1932x1910px.
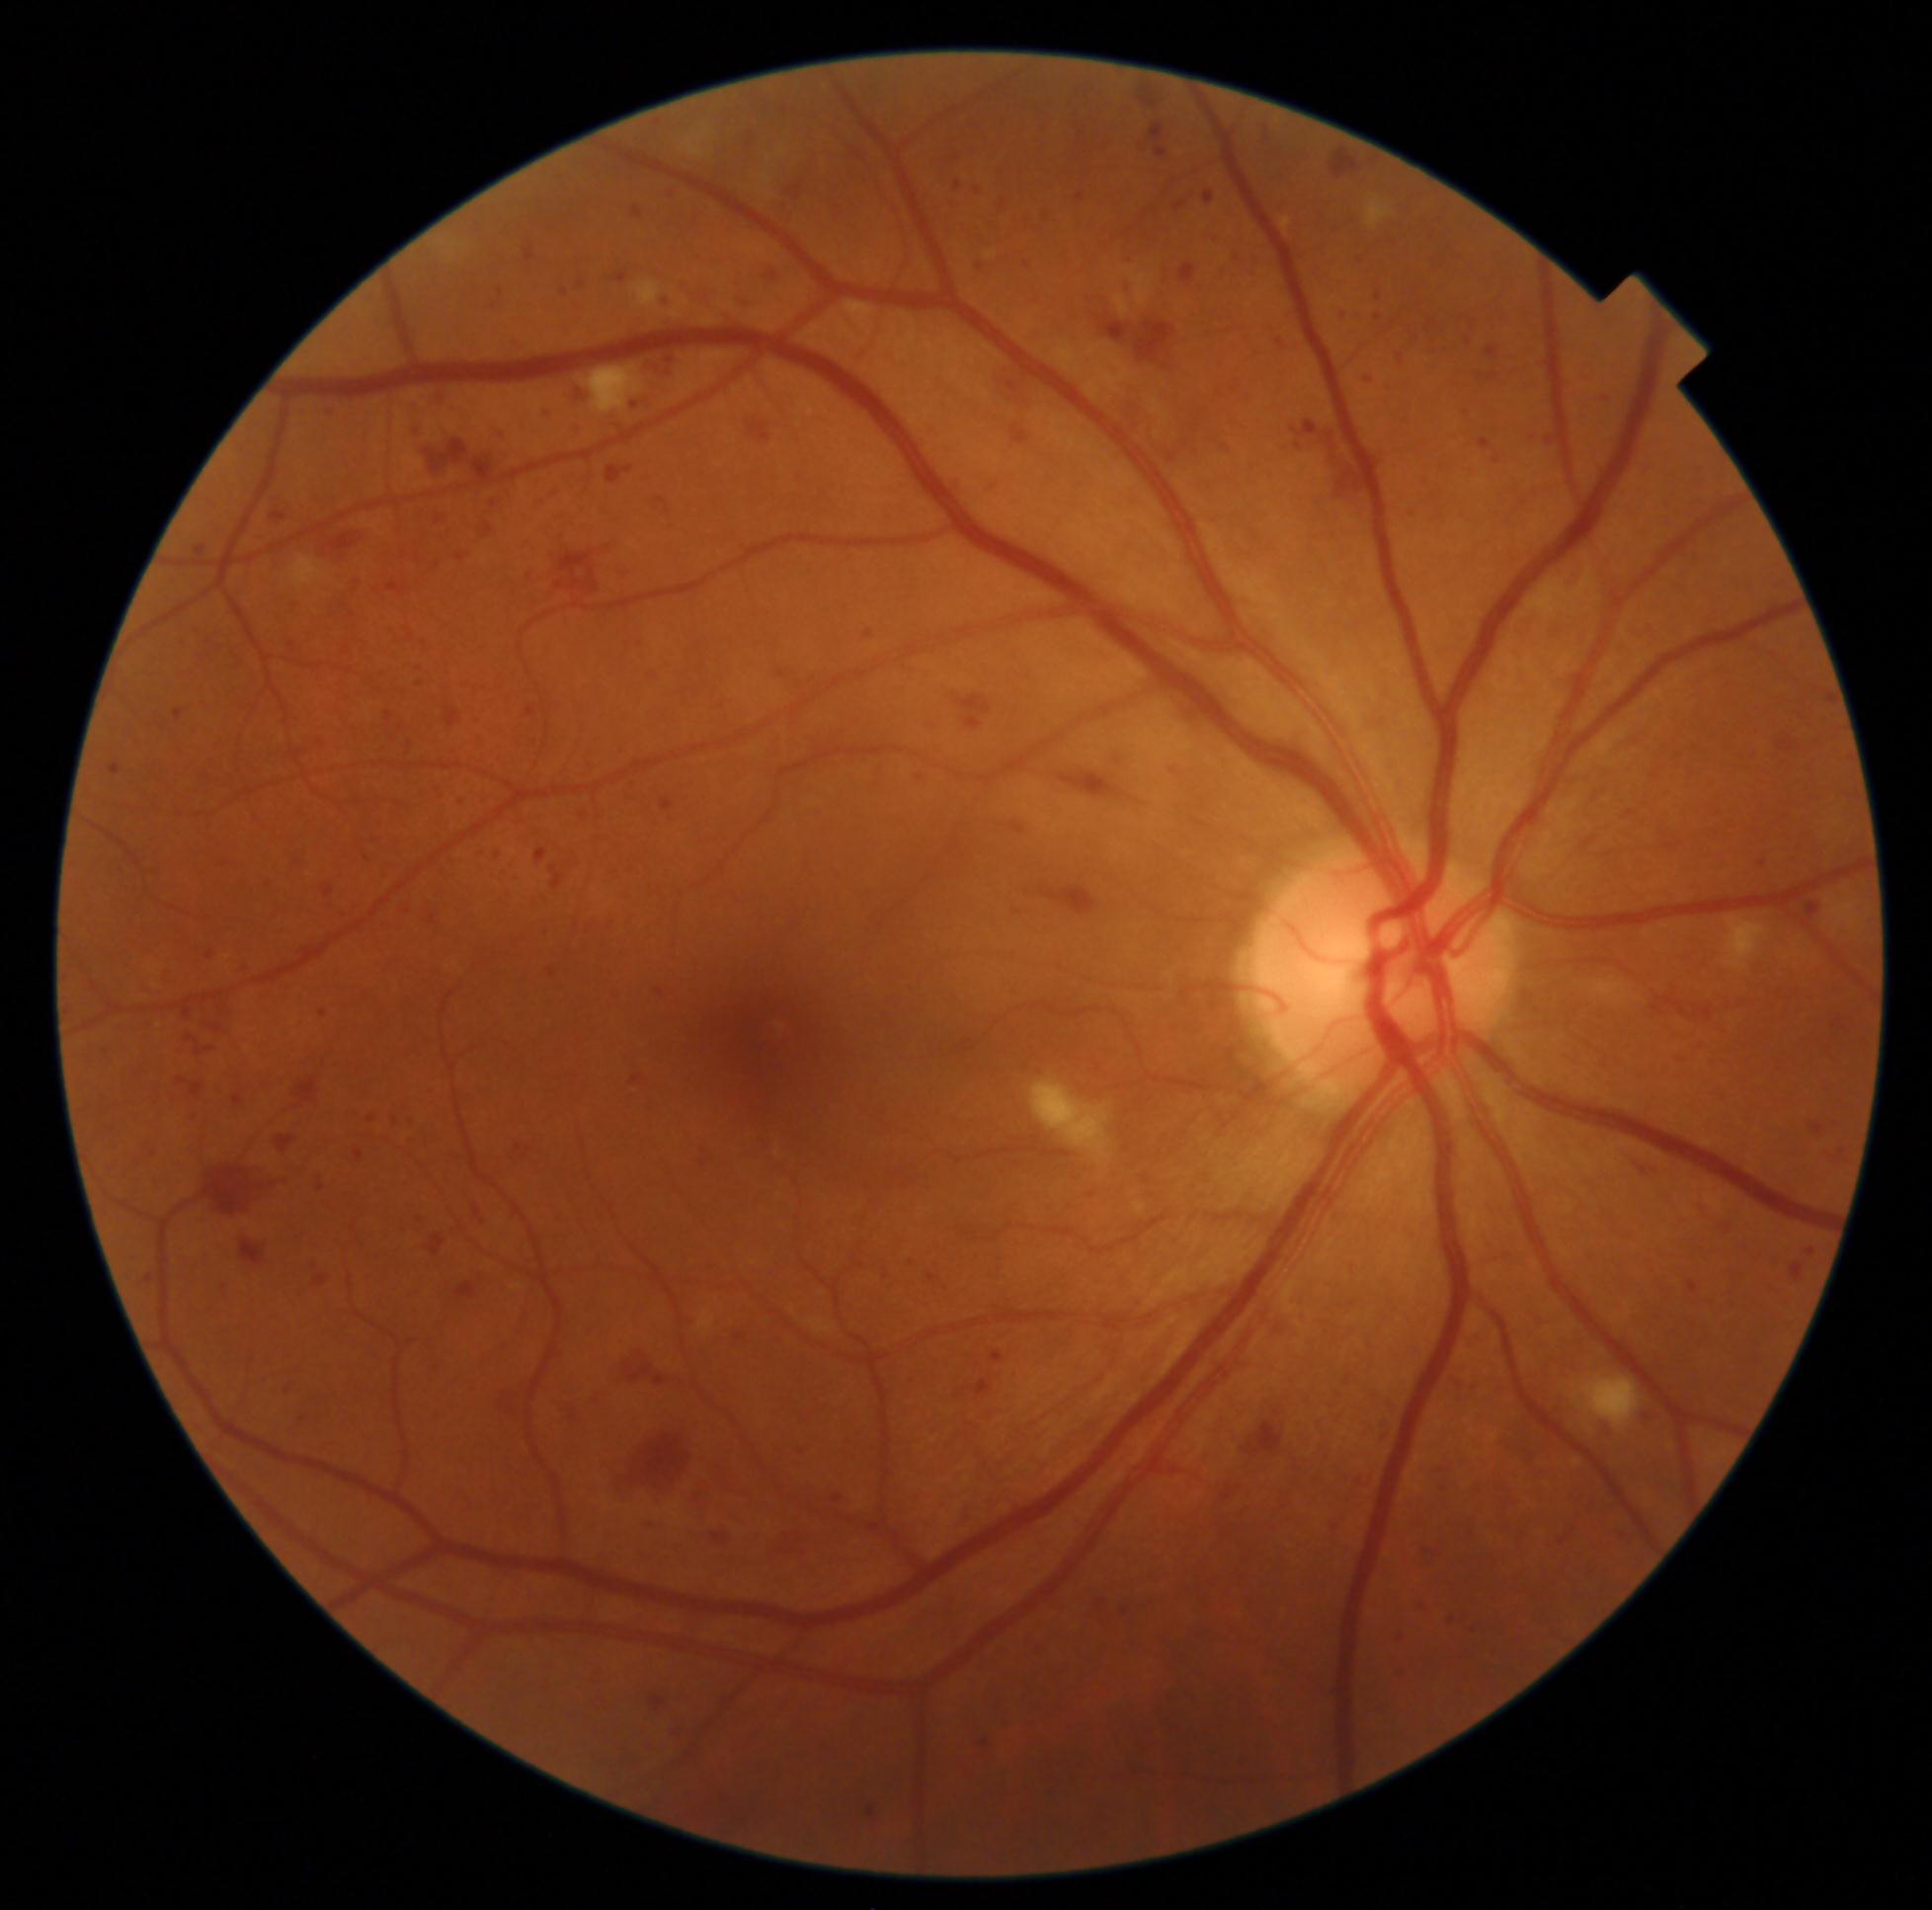

Retinopathy grade is 3
Selected lesions:
hemorrhages (subset): 1552 1334 1584 1377 | 833 1495 843 1504 | 1259 120 1275 147 | 256 496 345 544 | 506 337 526 353 | 418 637 429 653 | 491 501 498 509 | 859 628 873 644 | 442 1154 466 1173 | 1632 1159 1664 1177 | 920 719 937 735 | 382 1115 404 1129 | 229 1100 248 1113 | 1121 281 1134 296 | 320 1199 341 1217 | 65 967 73 985 | 384 624 396 635 | 1565 556 1587 592
Small hemorrhages approximately at (582; 285) | (1026; 266)